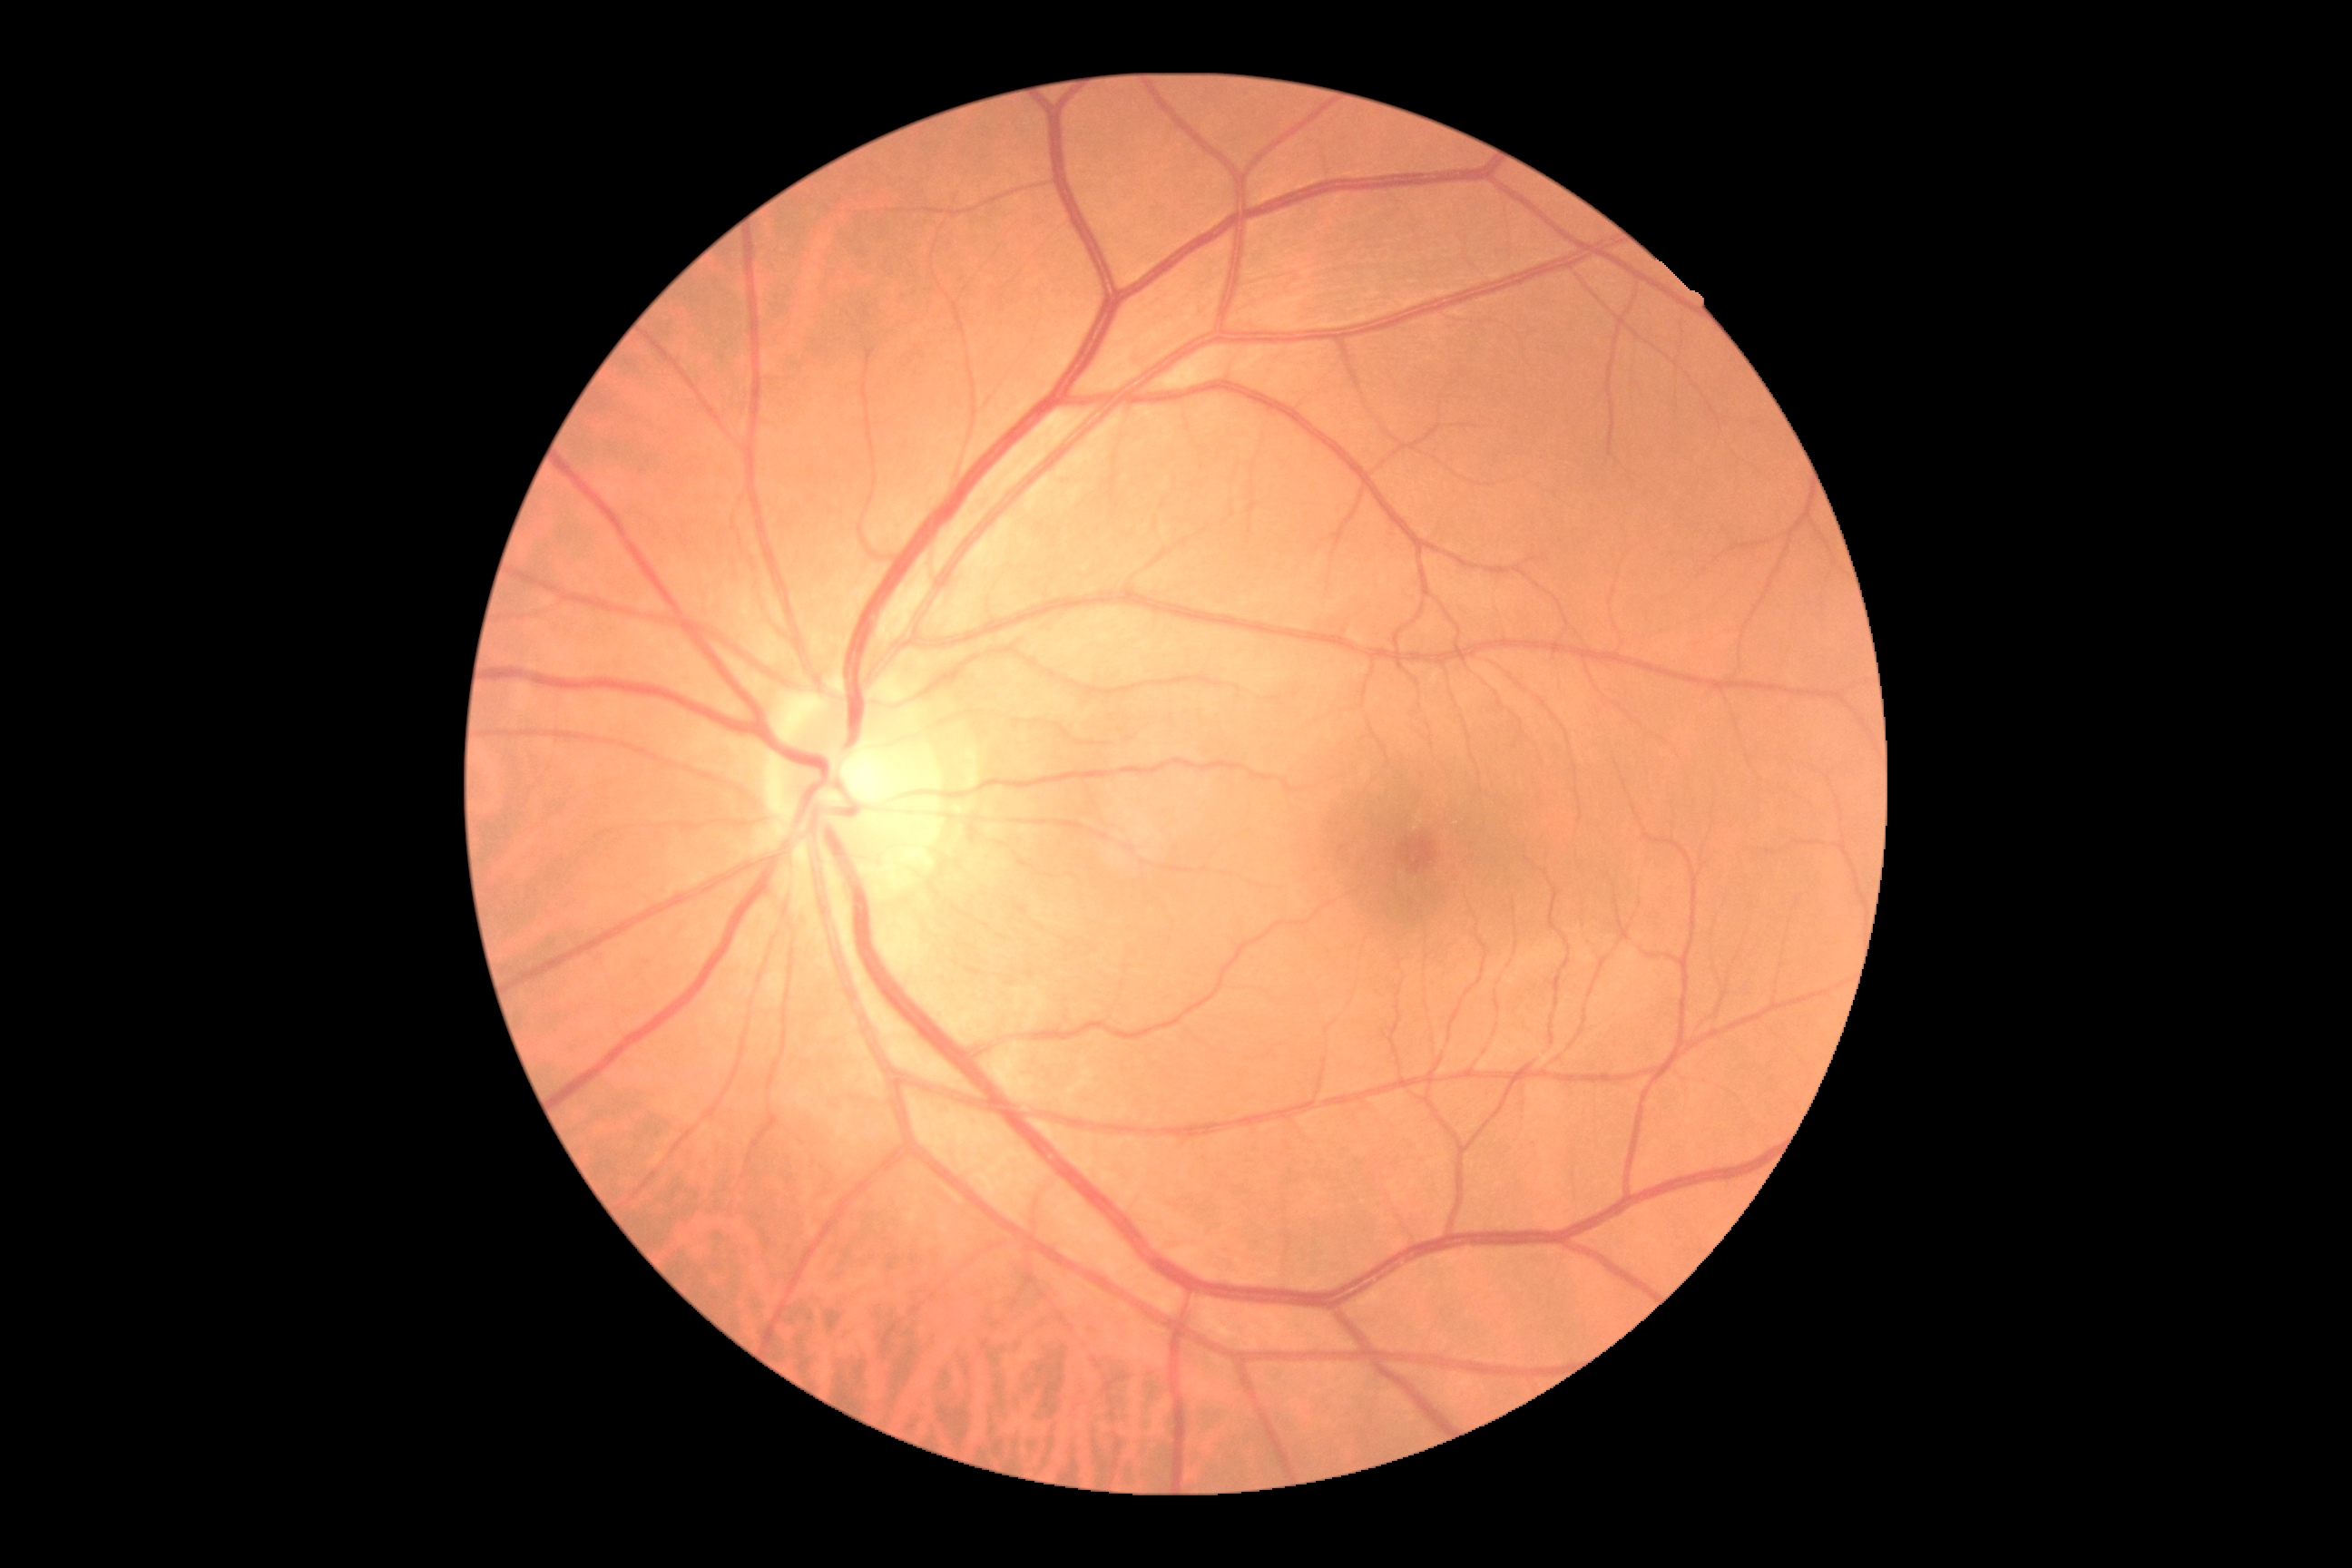
dr_grade: 0/4
dr_impression: negative for DR